2228 x 1652 pixels, 50° field of view.
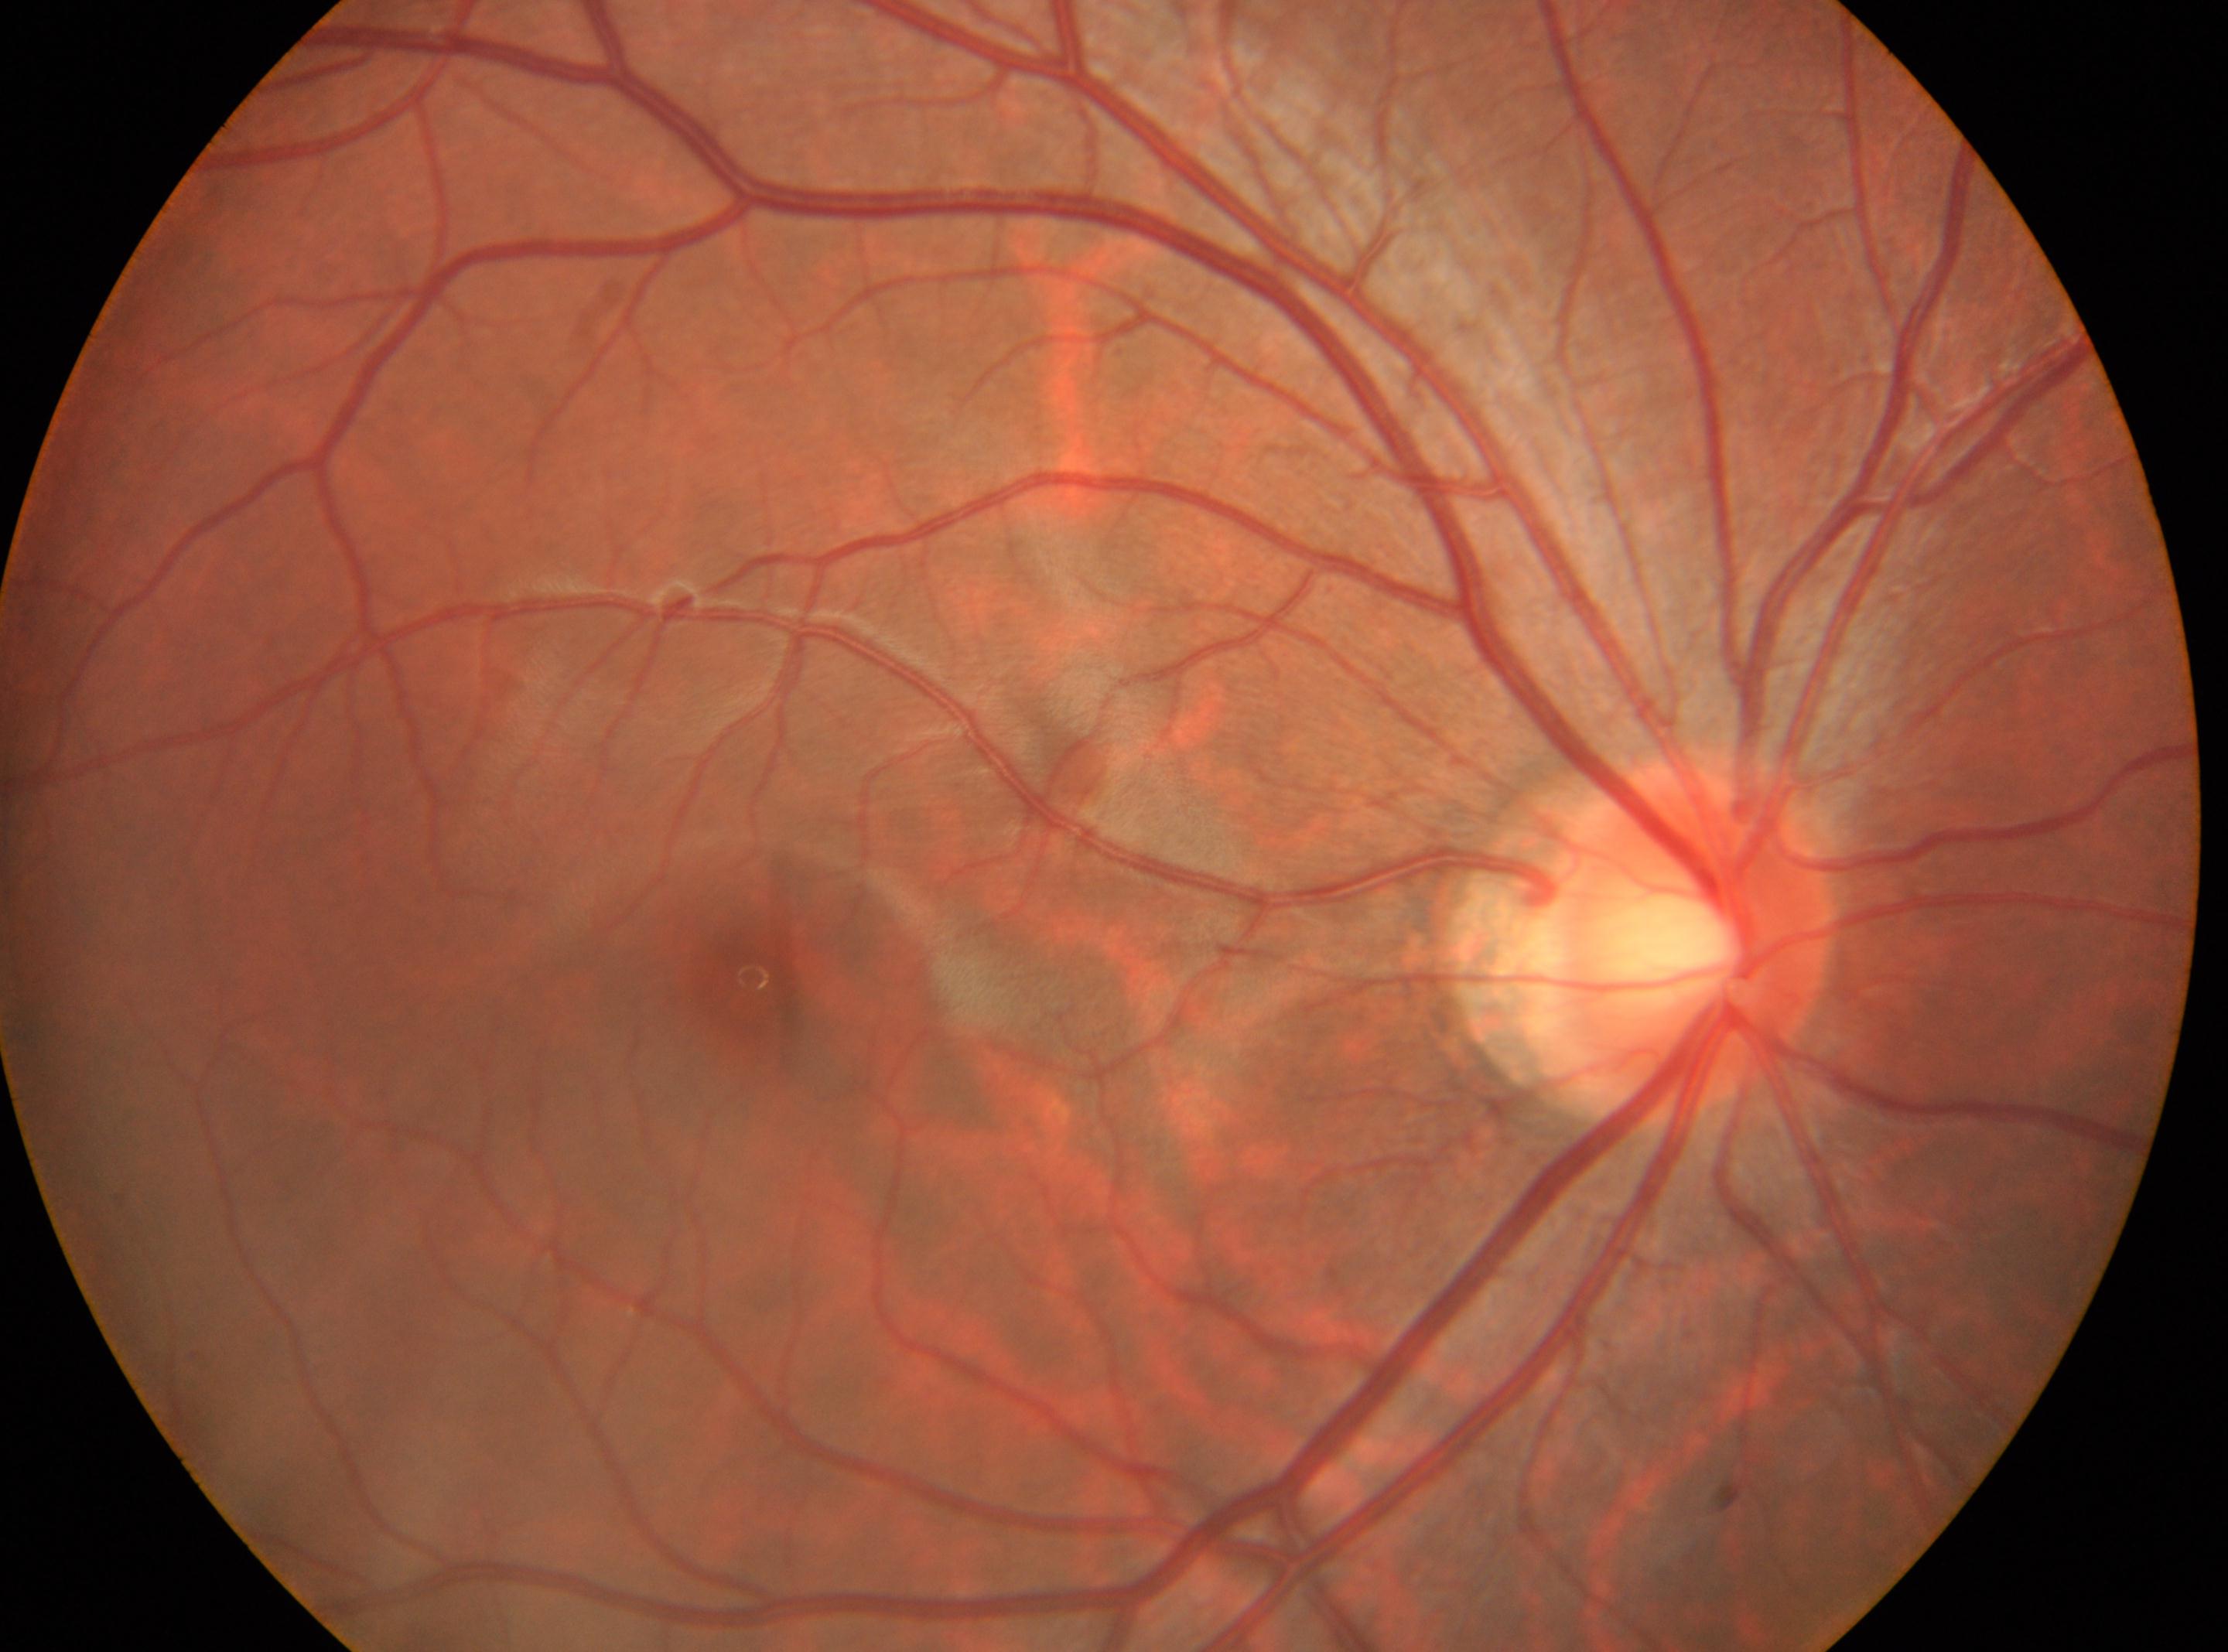 The foveal center is at (x: 753, y: 978). The optic nerve head is at (x: 1687, y: 931). DR stage is 0. Eye: OD.